50° FOV. Mydriatic (tropicamide and phenylephrine). Image size 2228x1652.
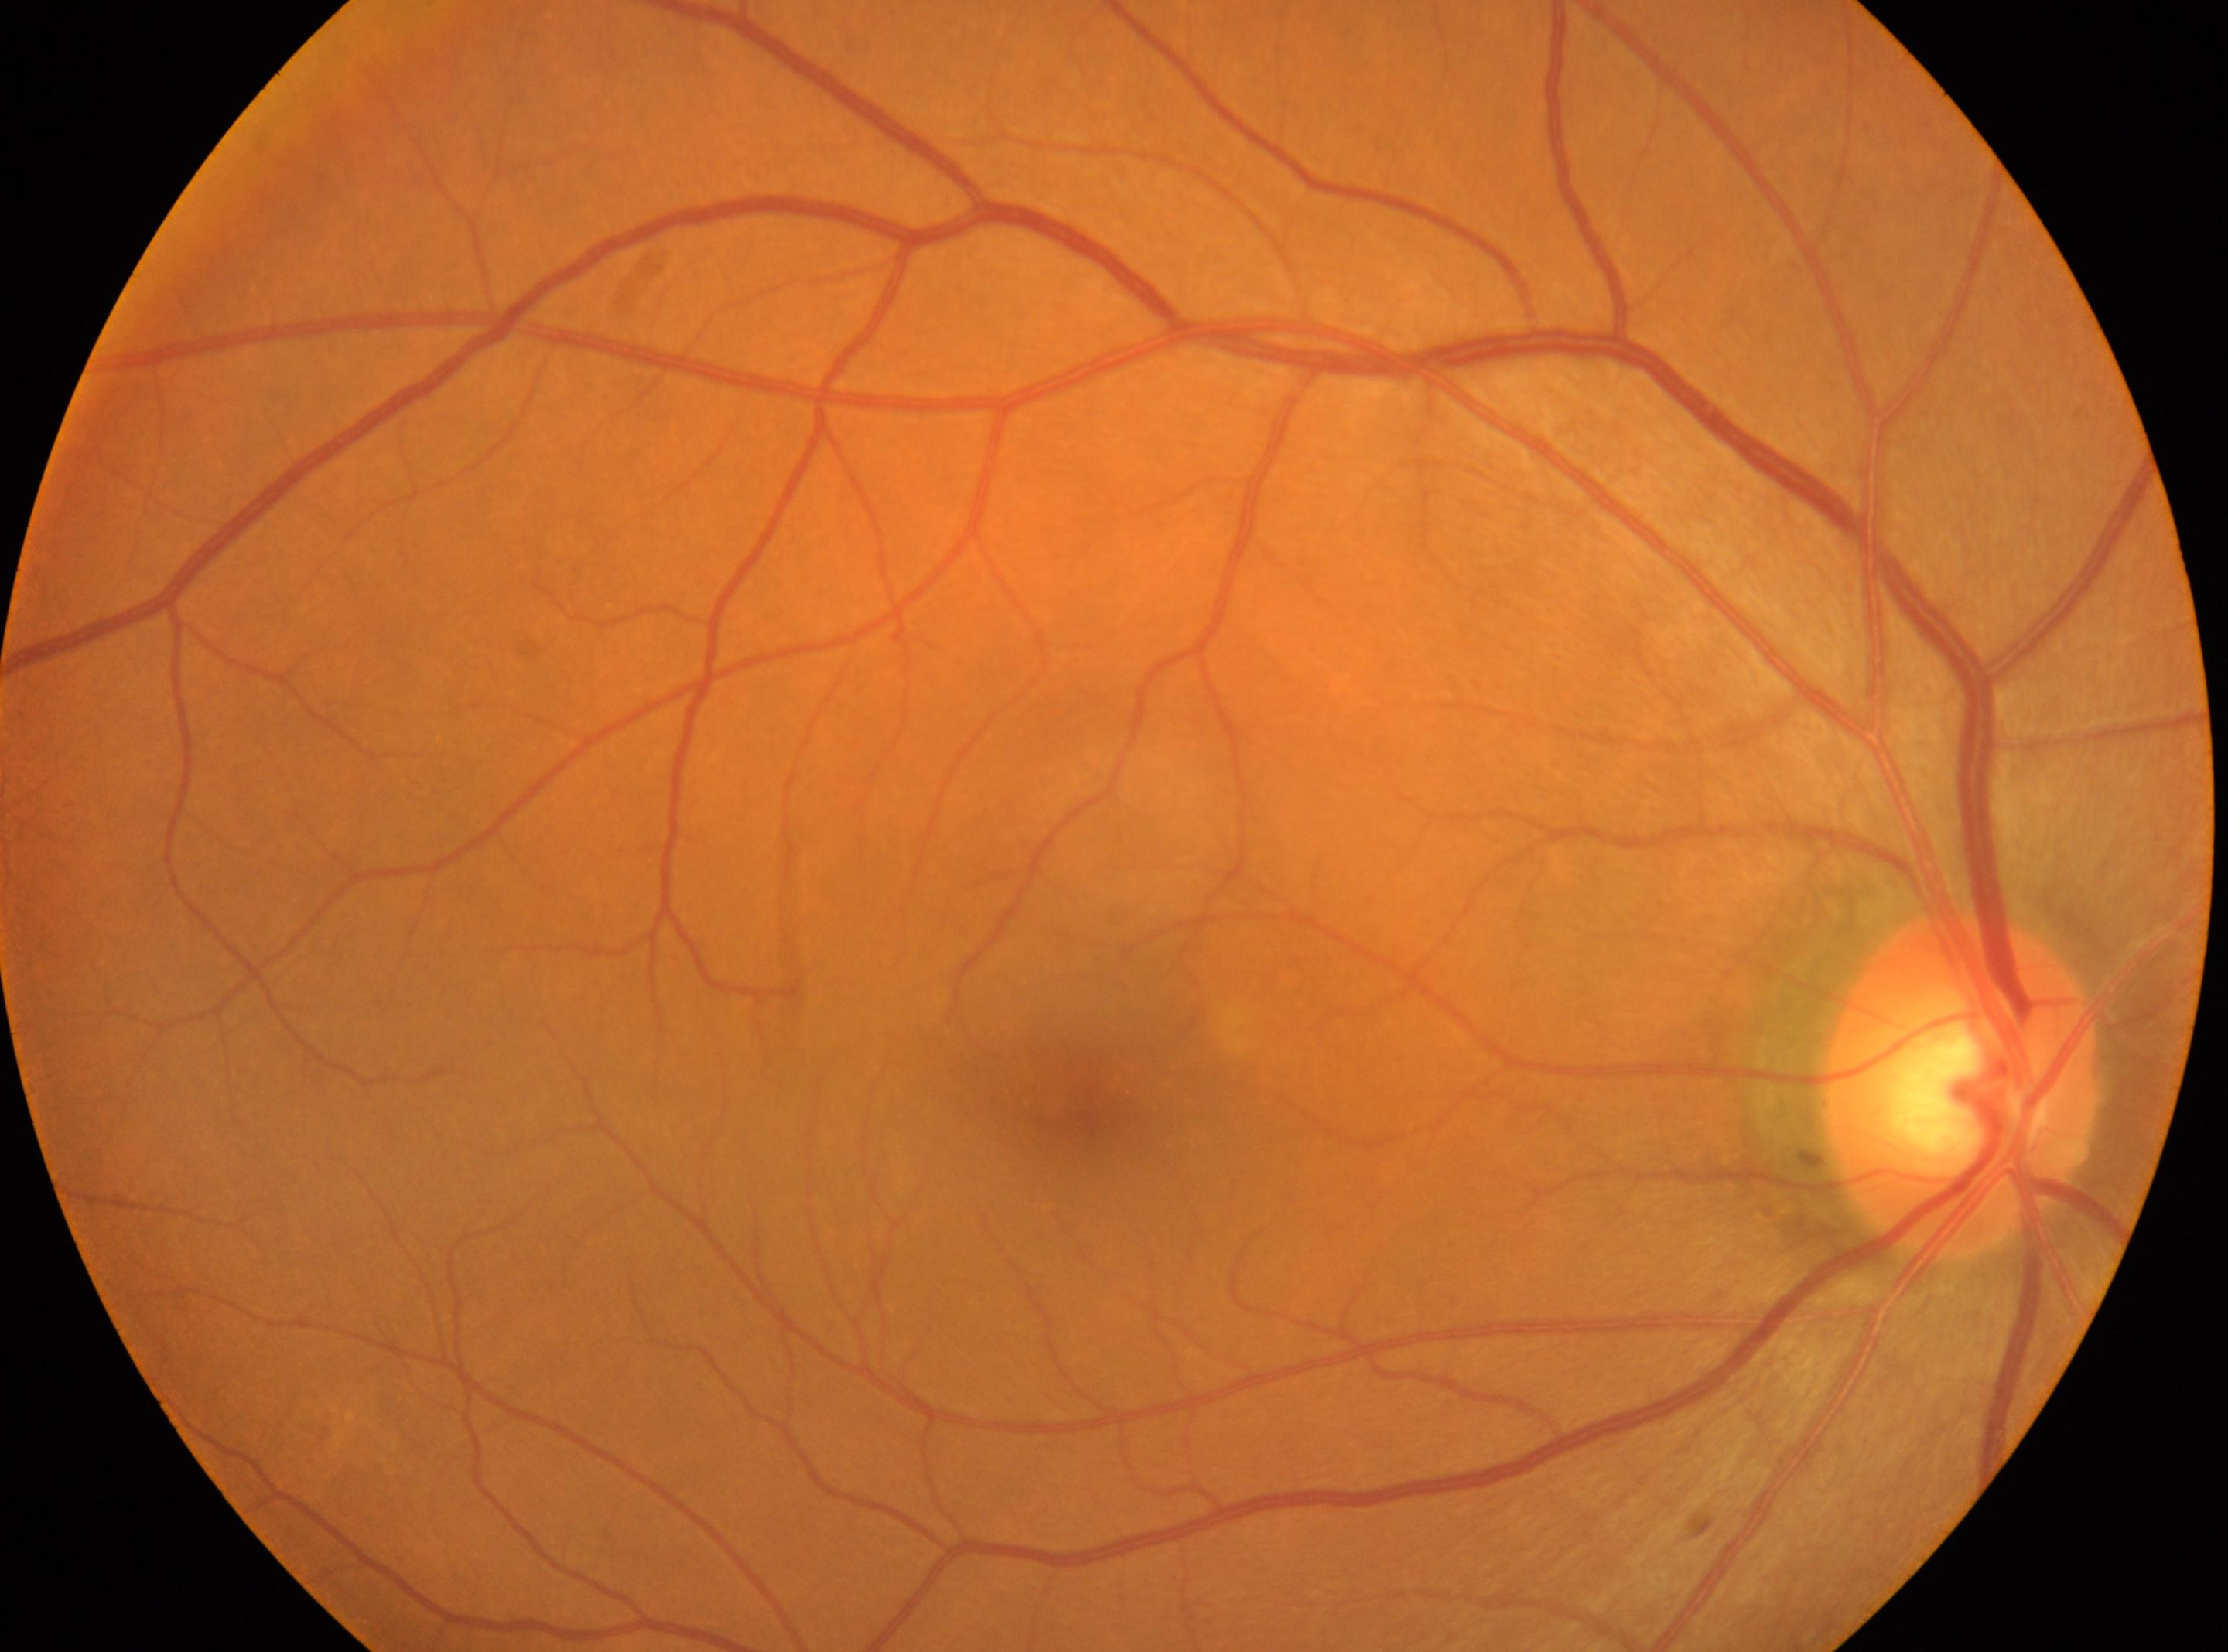
Q: What is the laterality?
A: OD
Q: Locate the optic disc.
A: (x: 1959, y: 1086)
Q: What is the DR grade?
A: 0 — no visible signs of diabetic retinopathy
Q: Locate the fovea.
A: (x: 1083, y: 1101)